Graded on the modified Davis scale: 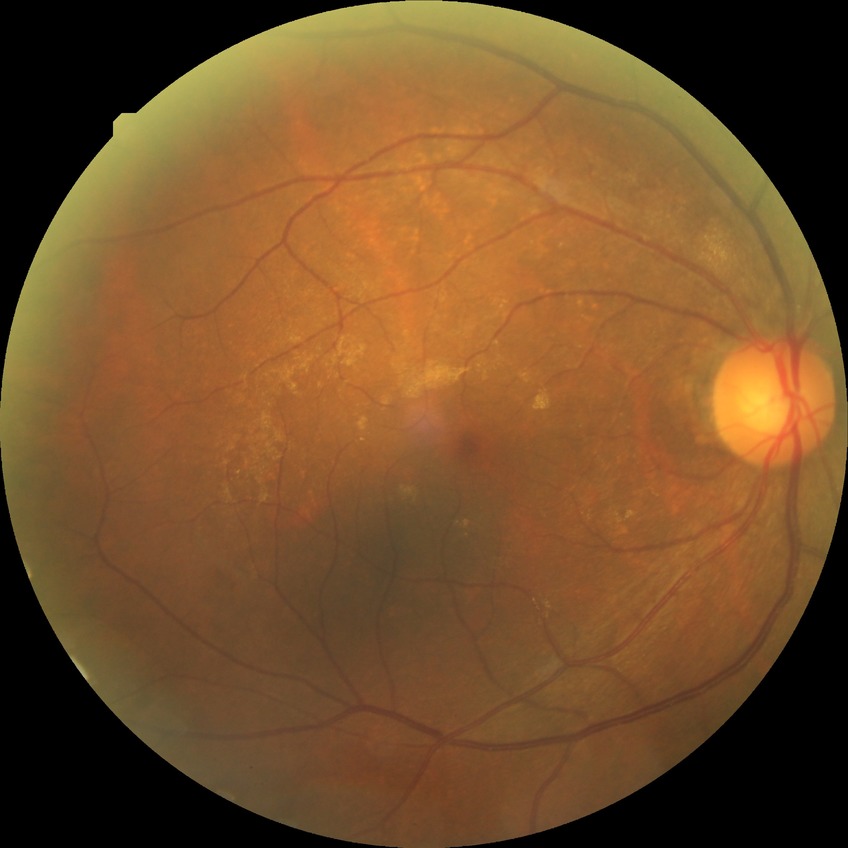
diabetic retinopathy (DR)=NDR (no diabetic retinopathy).